45° FOV · without pupil dilation · graded on the modified Davis scale · CFP · 848x848px — 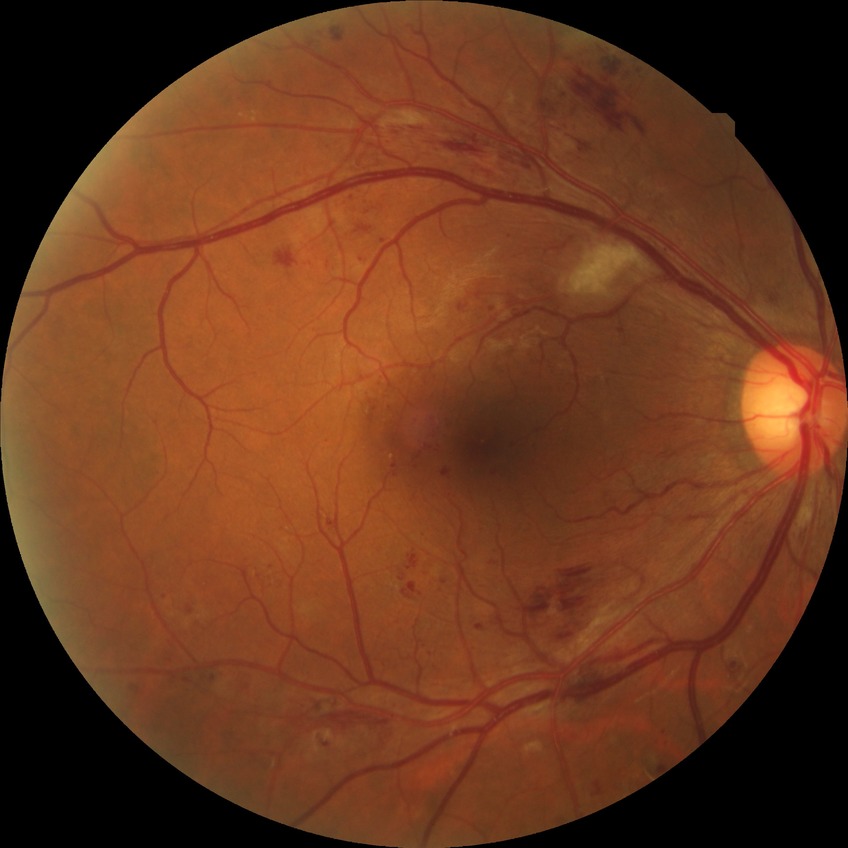 Diabetic retinopathy (DR) is PPDR (pre-proliferative diabetic retinopathy).